Wide-field contact fundus photograph of an infant:
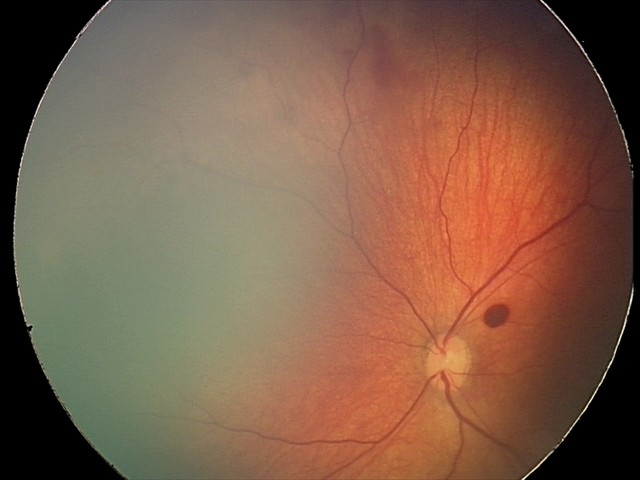

Q: What was the screening finding?
A: retinal hemorrhages